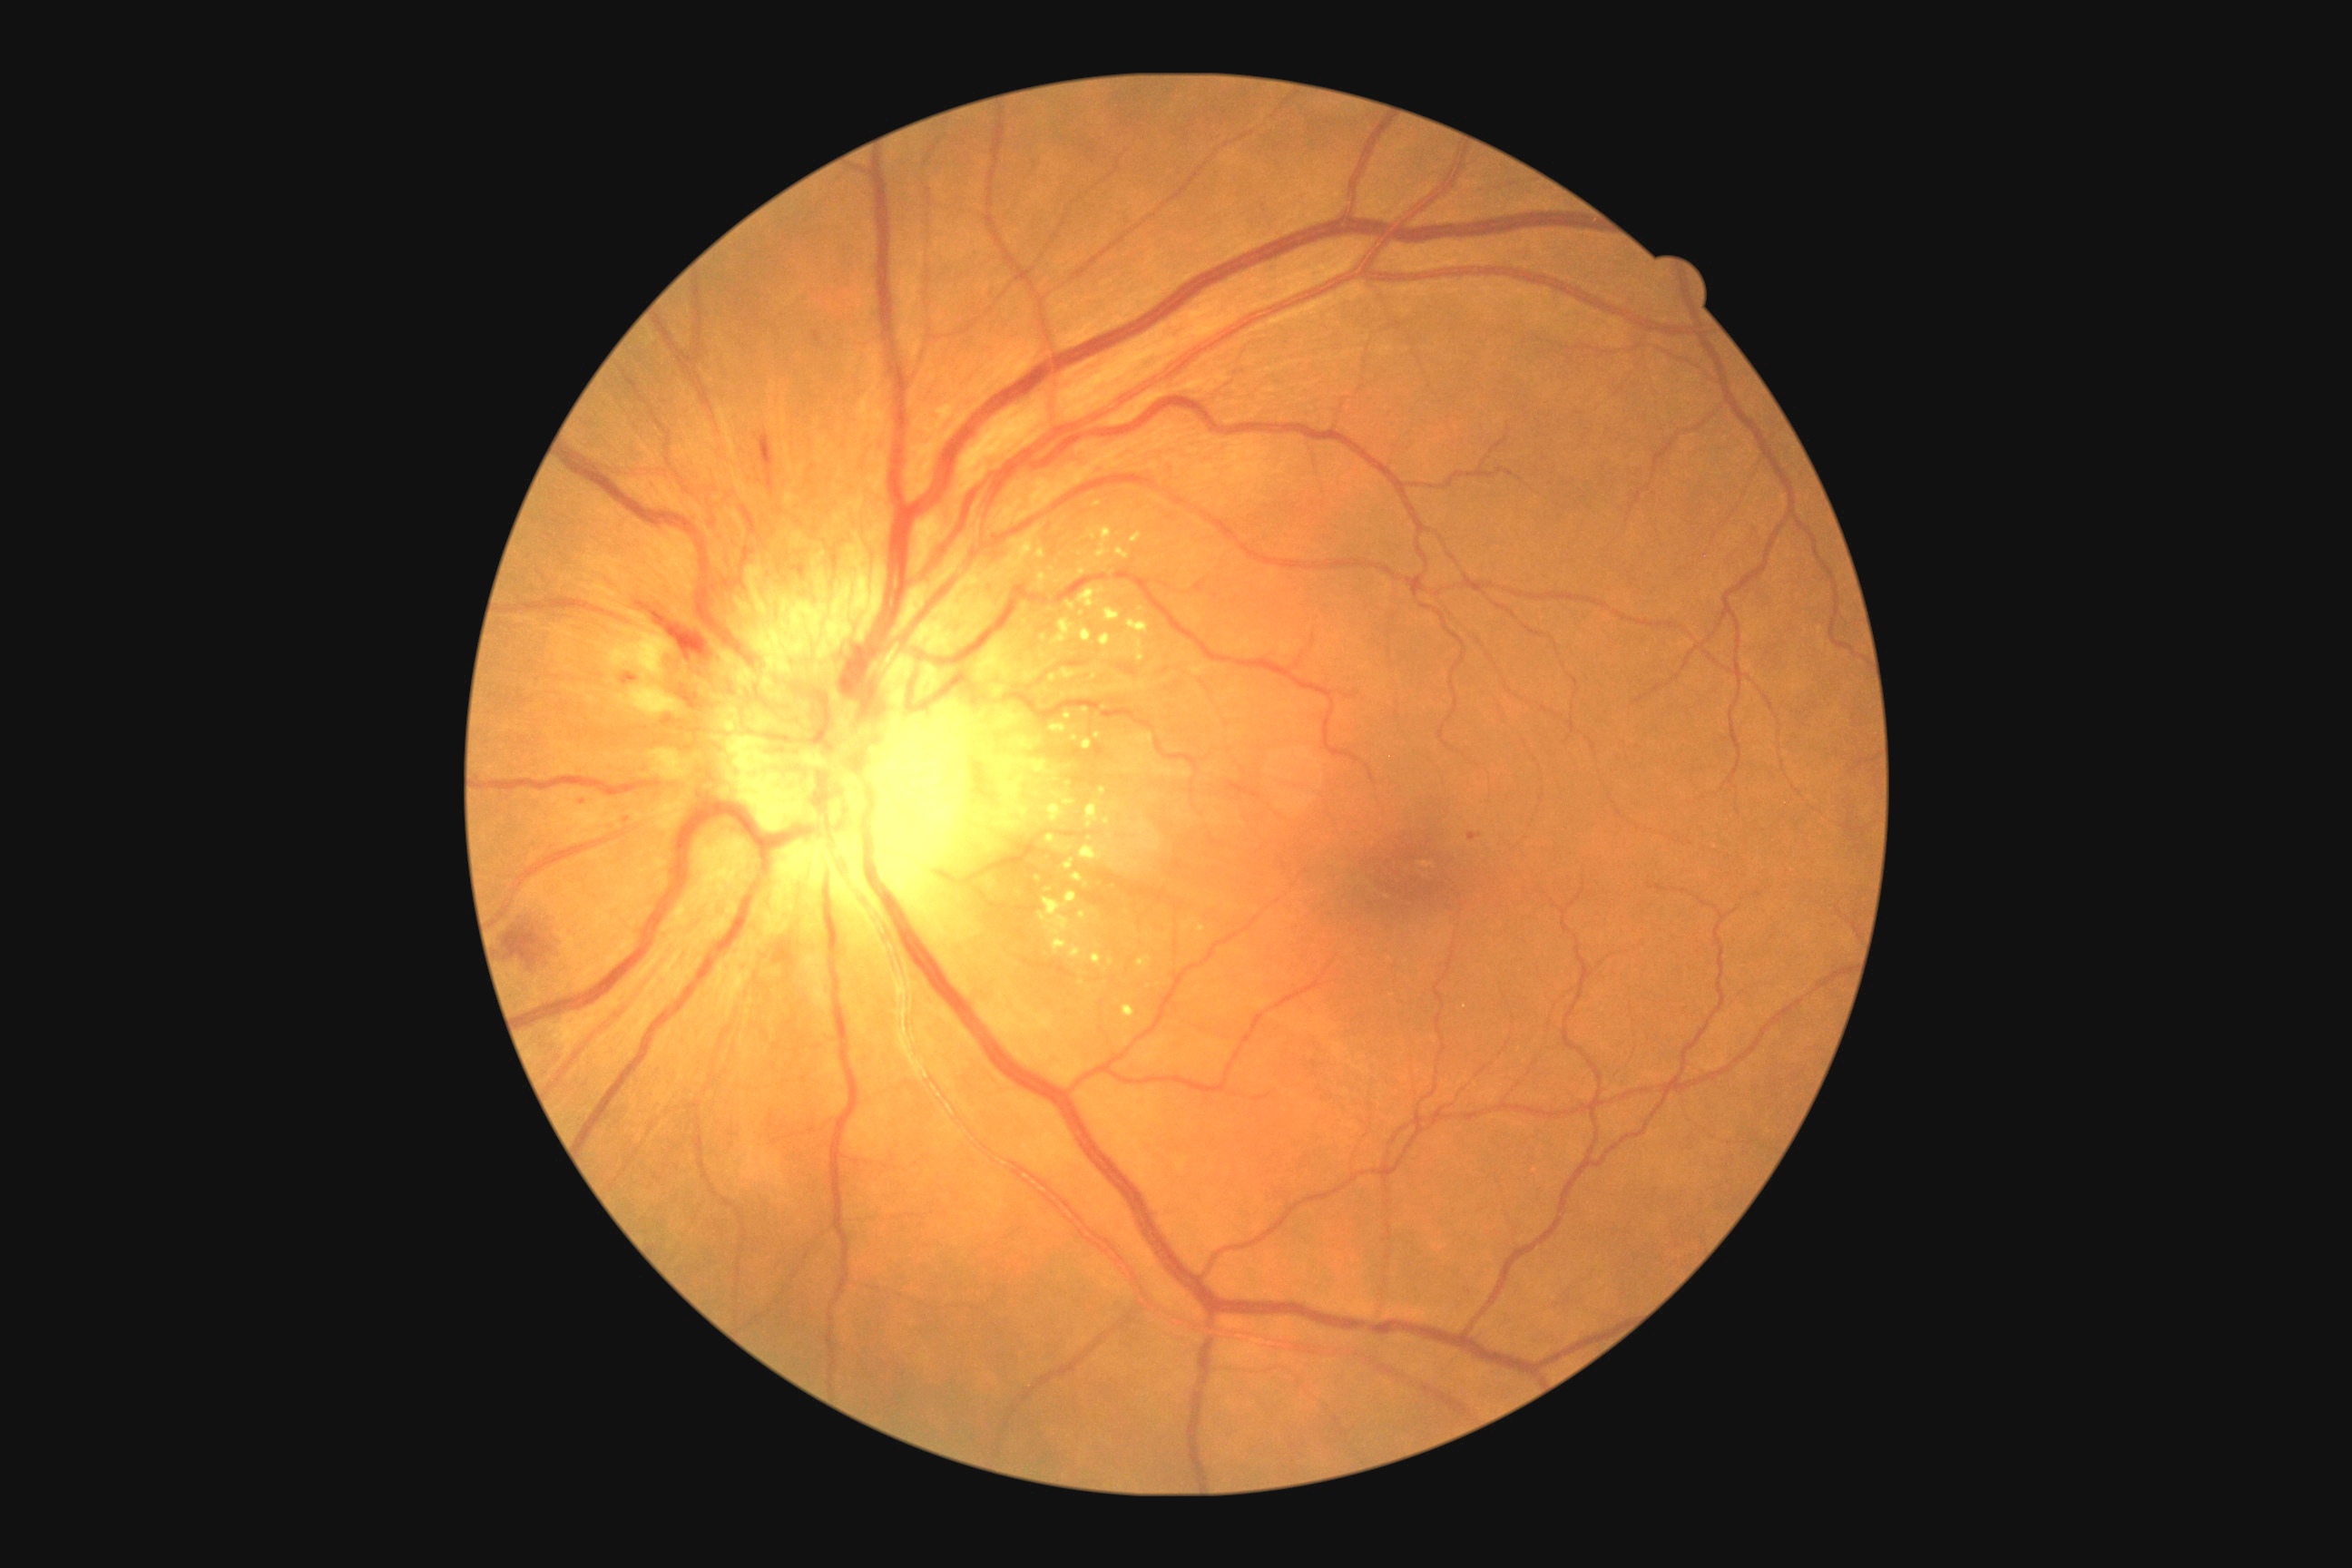
DR grade: PDR (4).